RetCam wide-field infant fundus image — 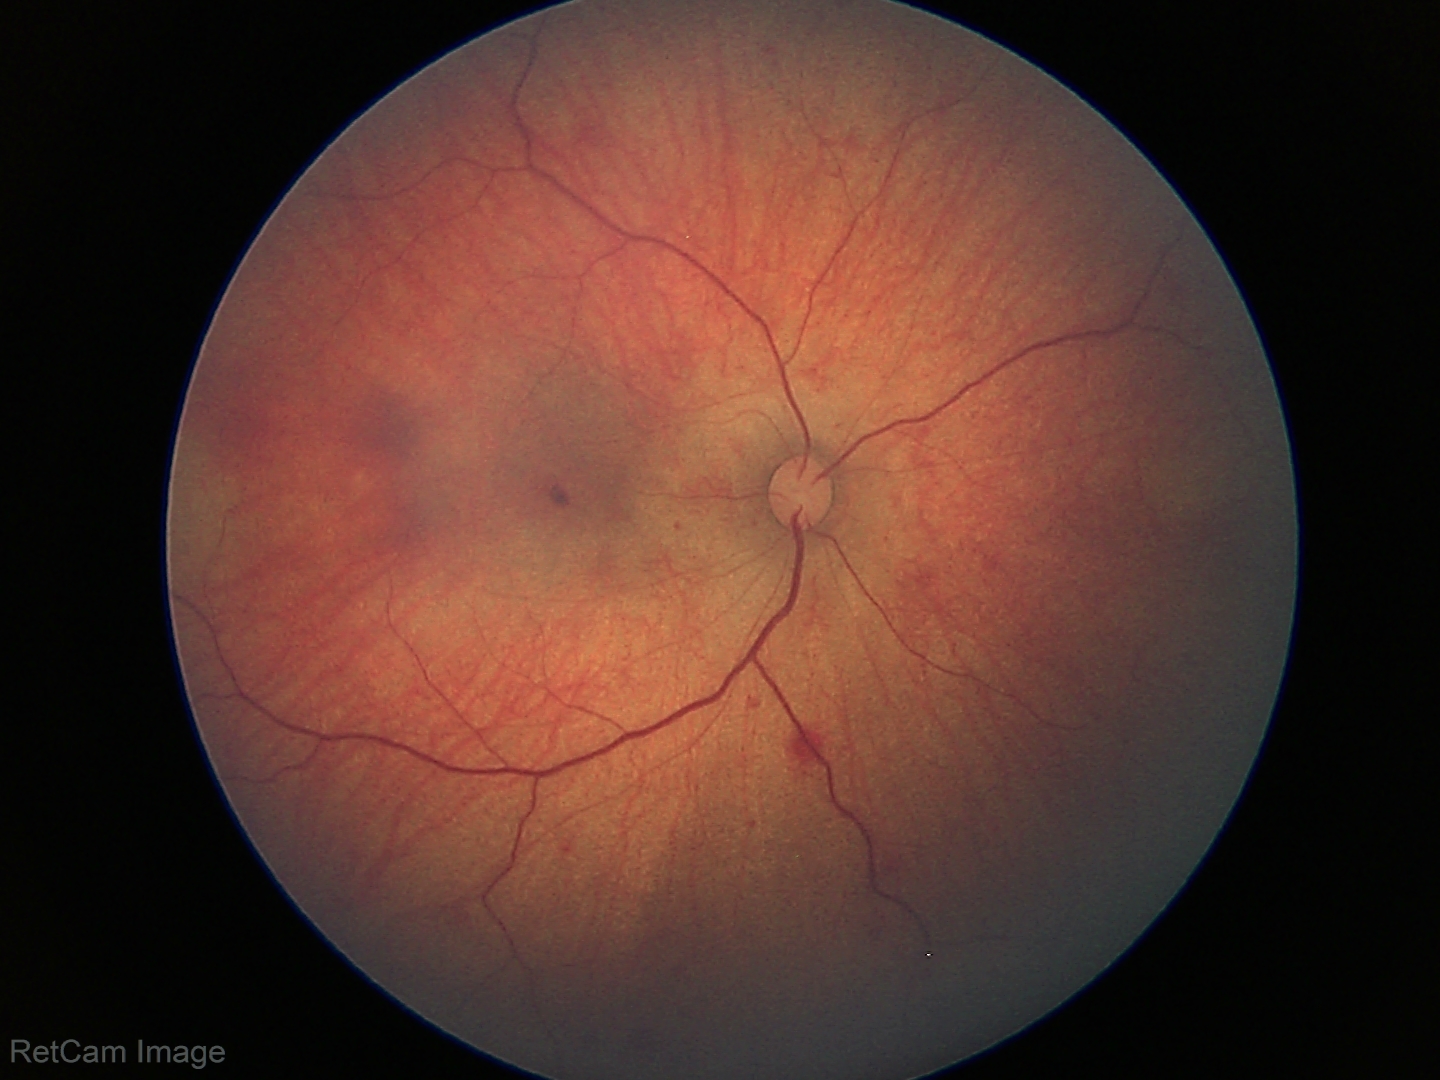 Examination diagnosed as retinal hemorrhages.